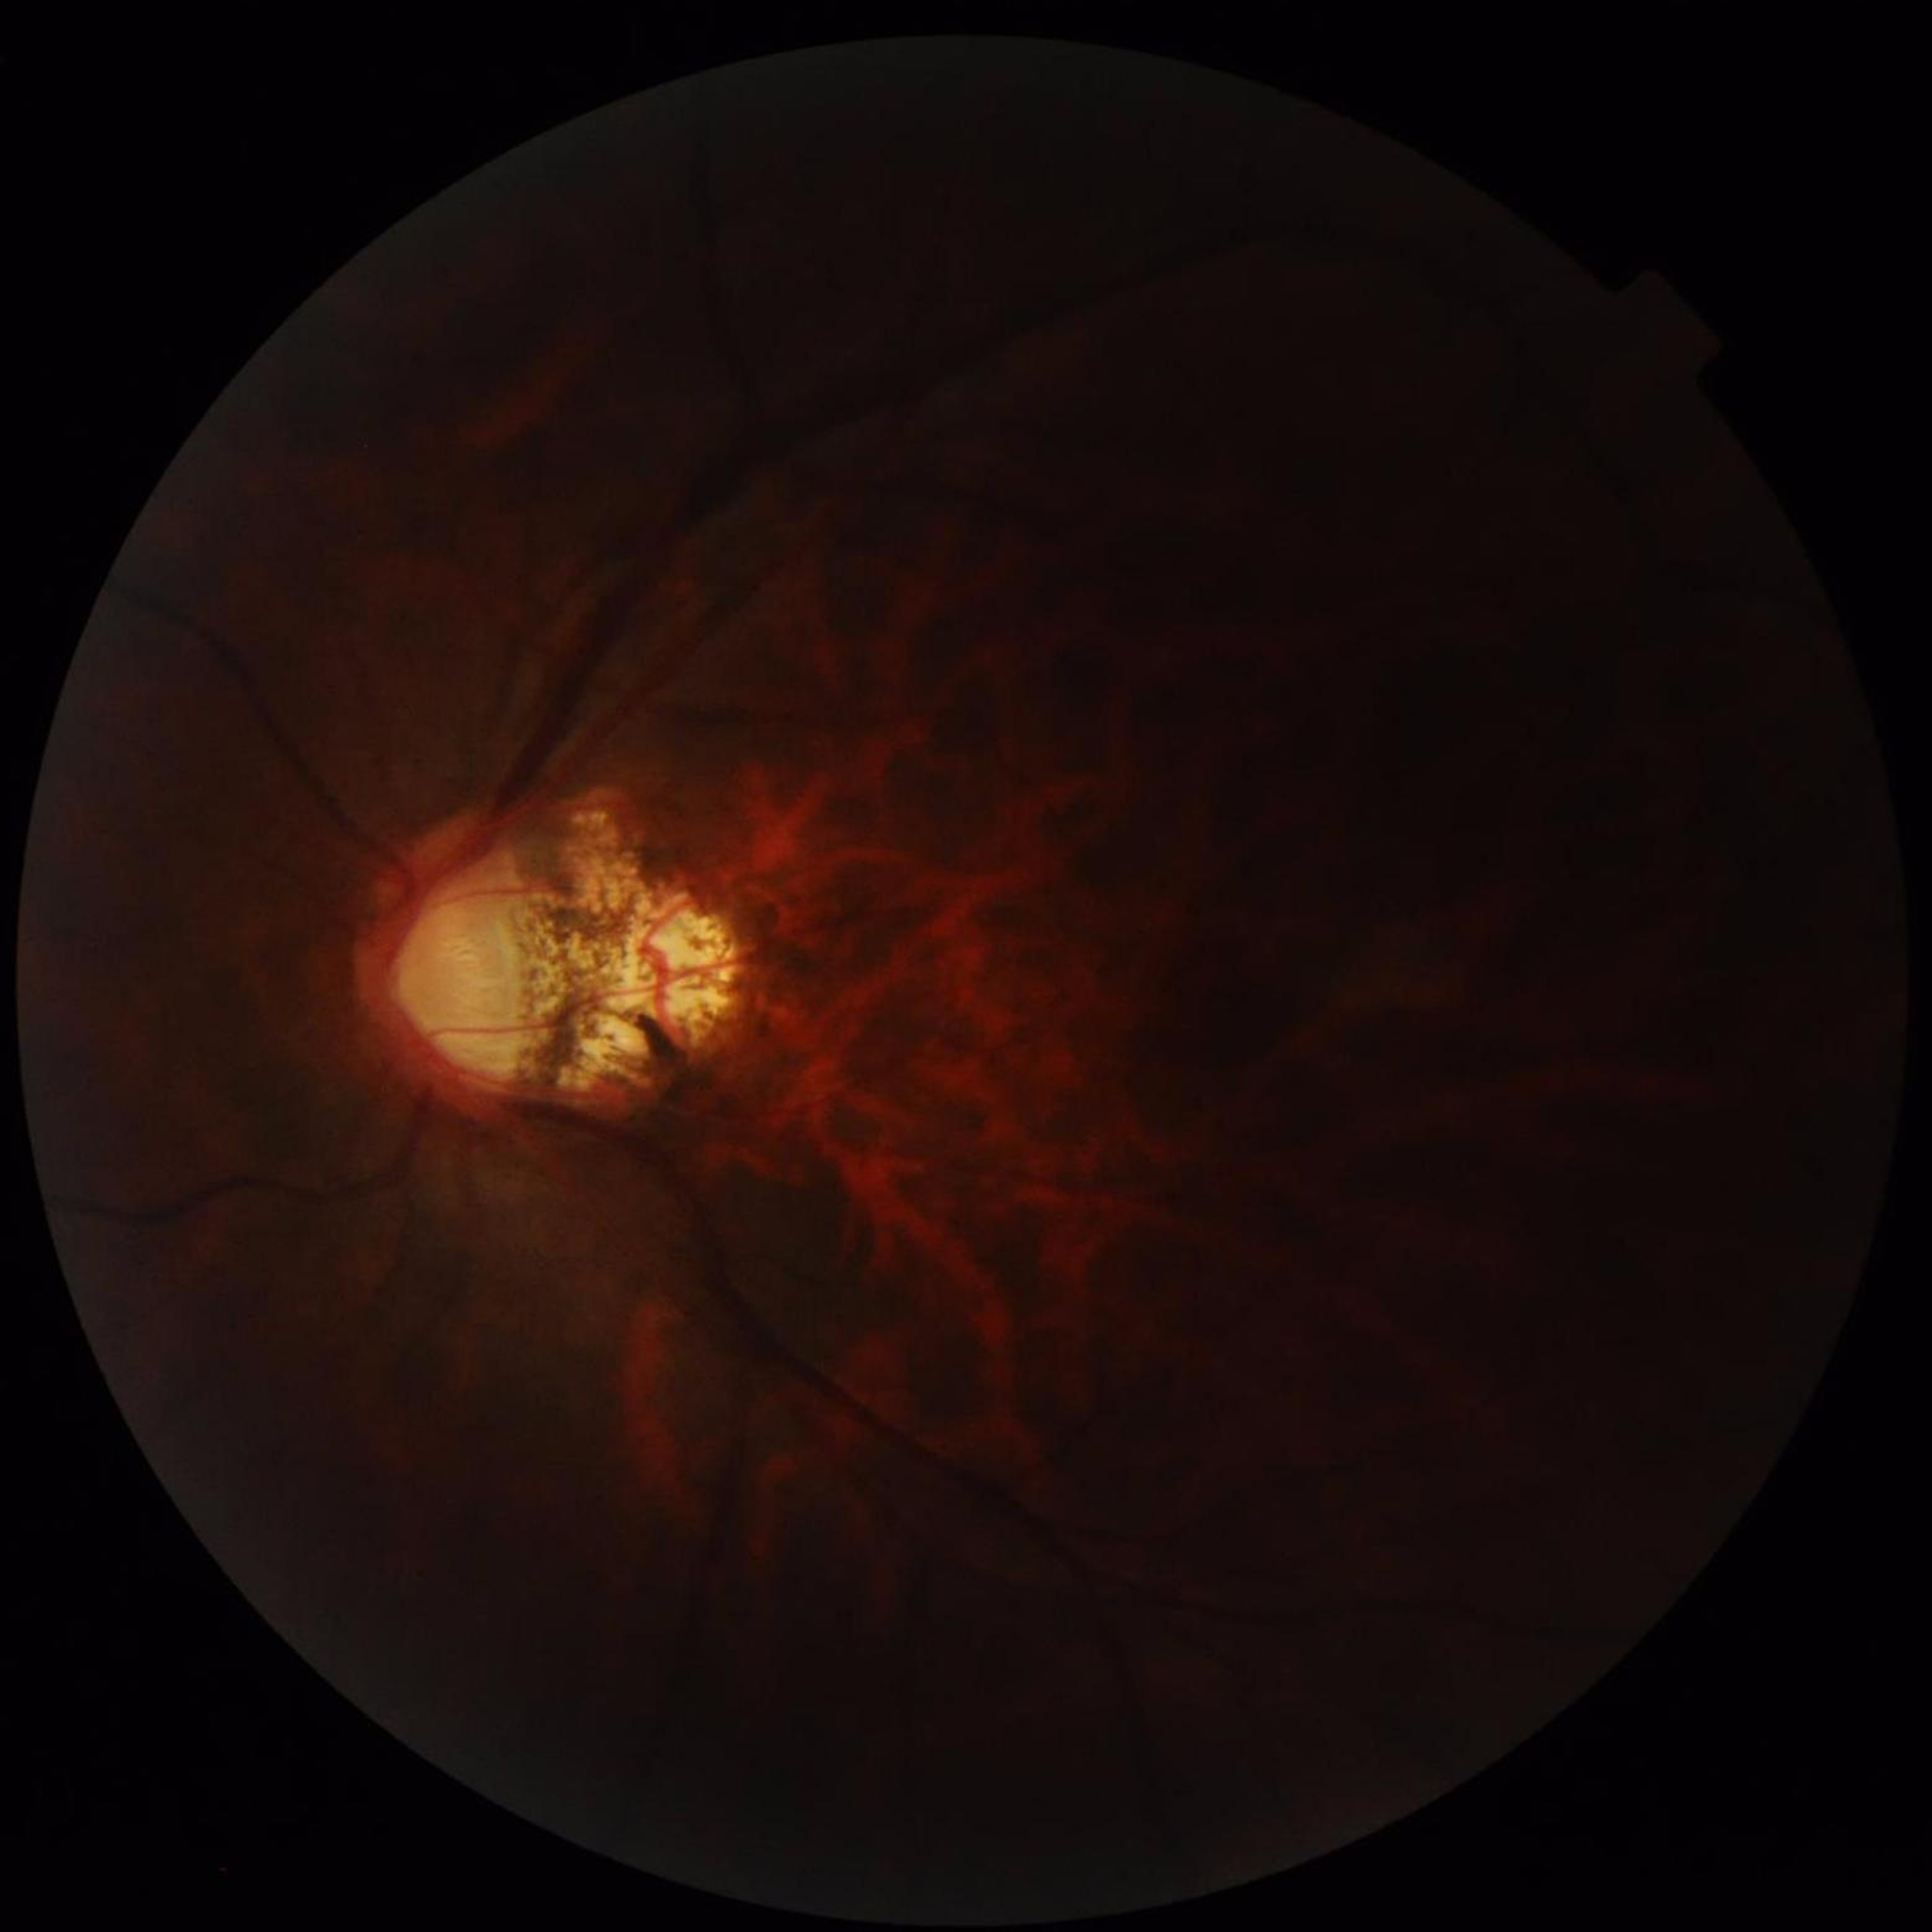
Clinical diagnosis: glaucoma.